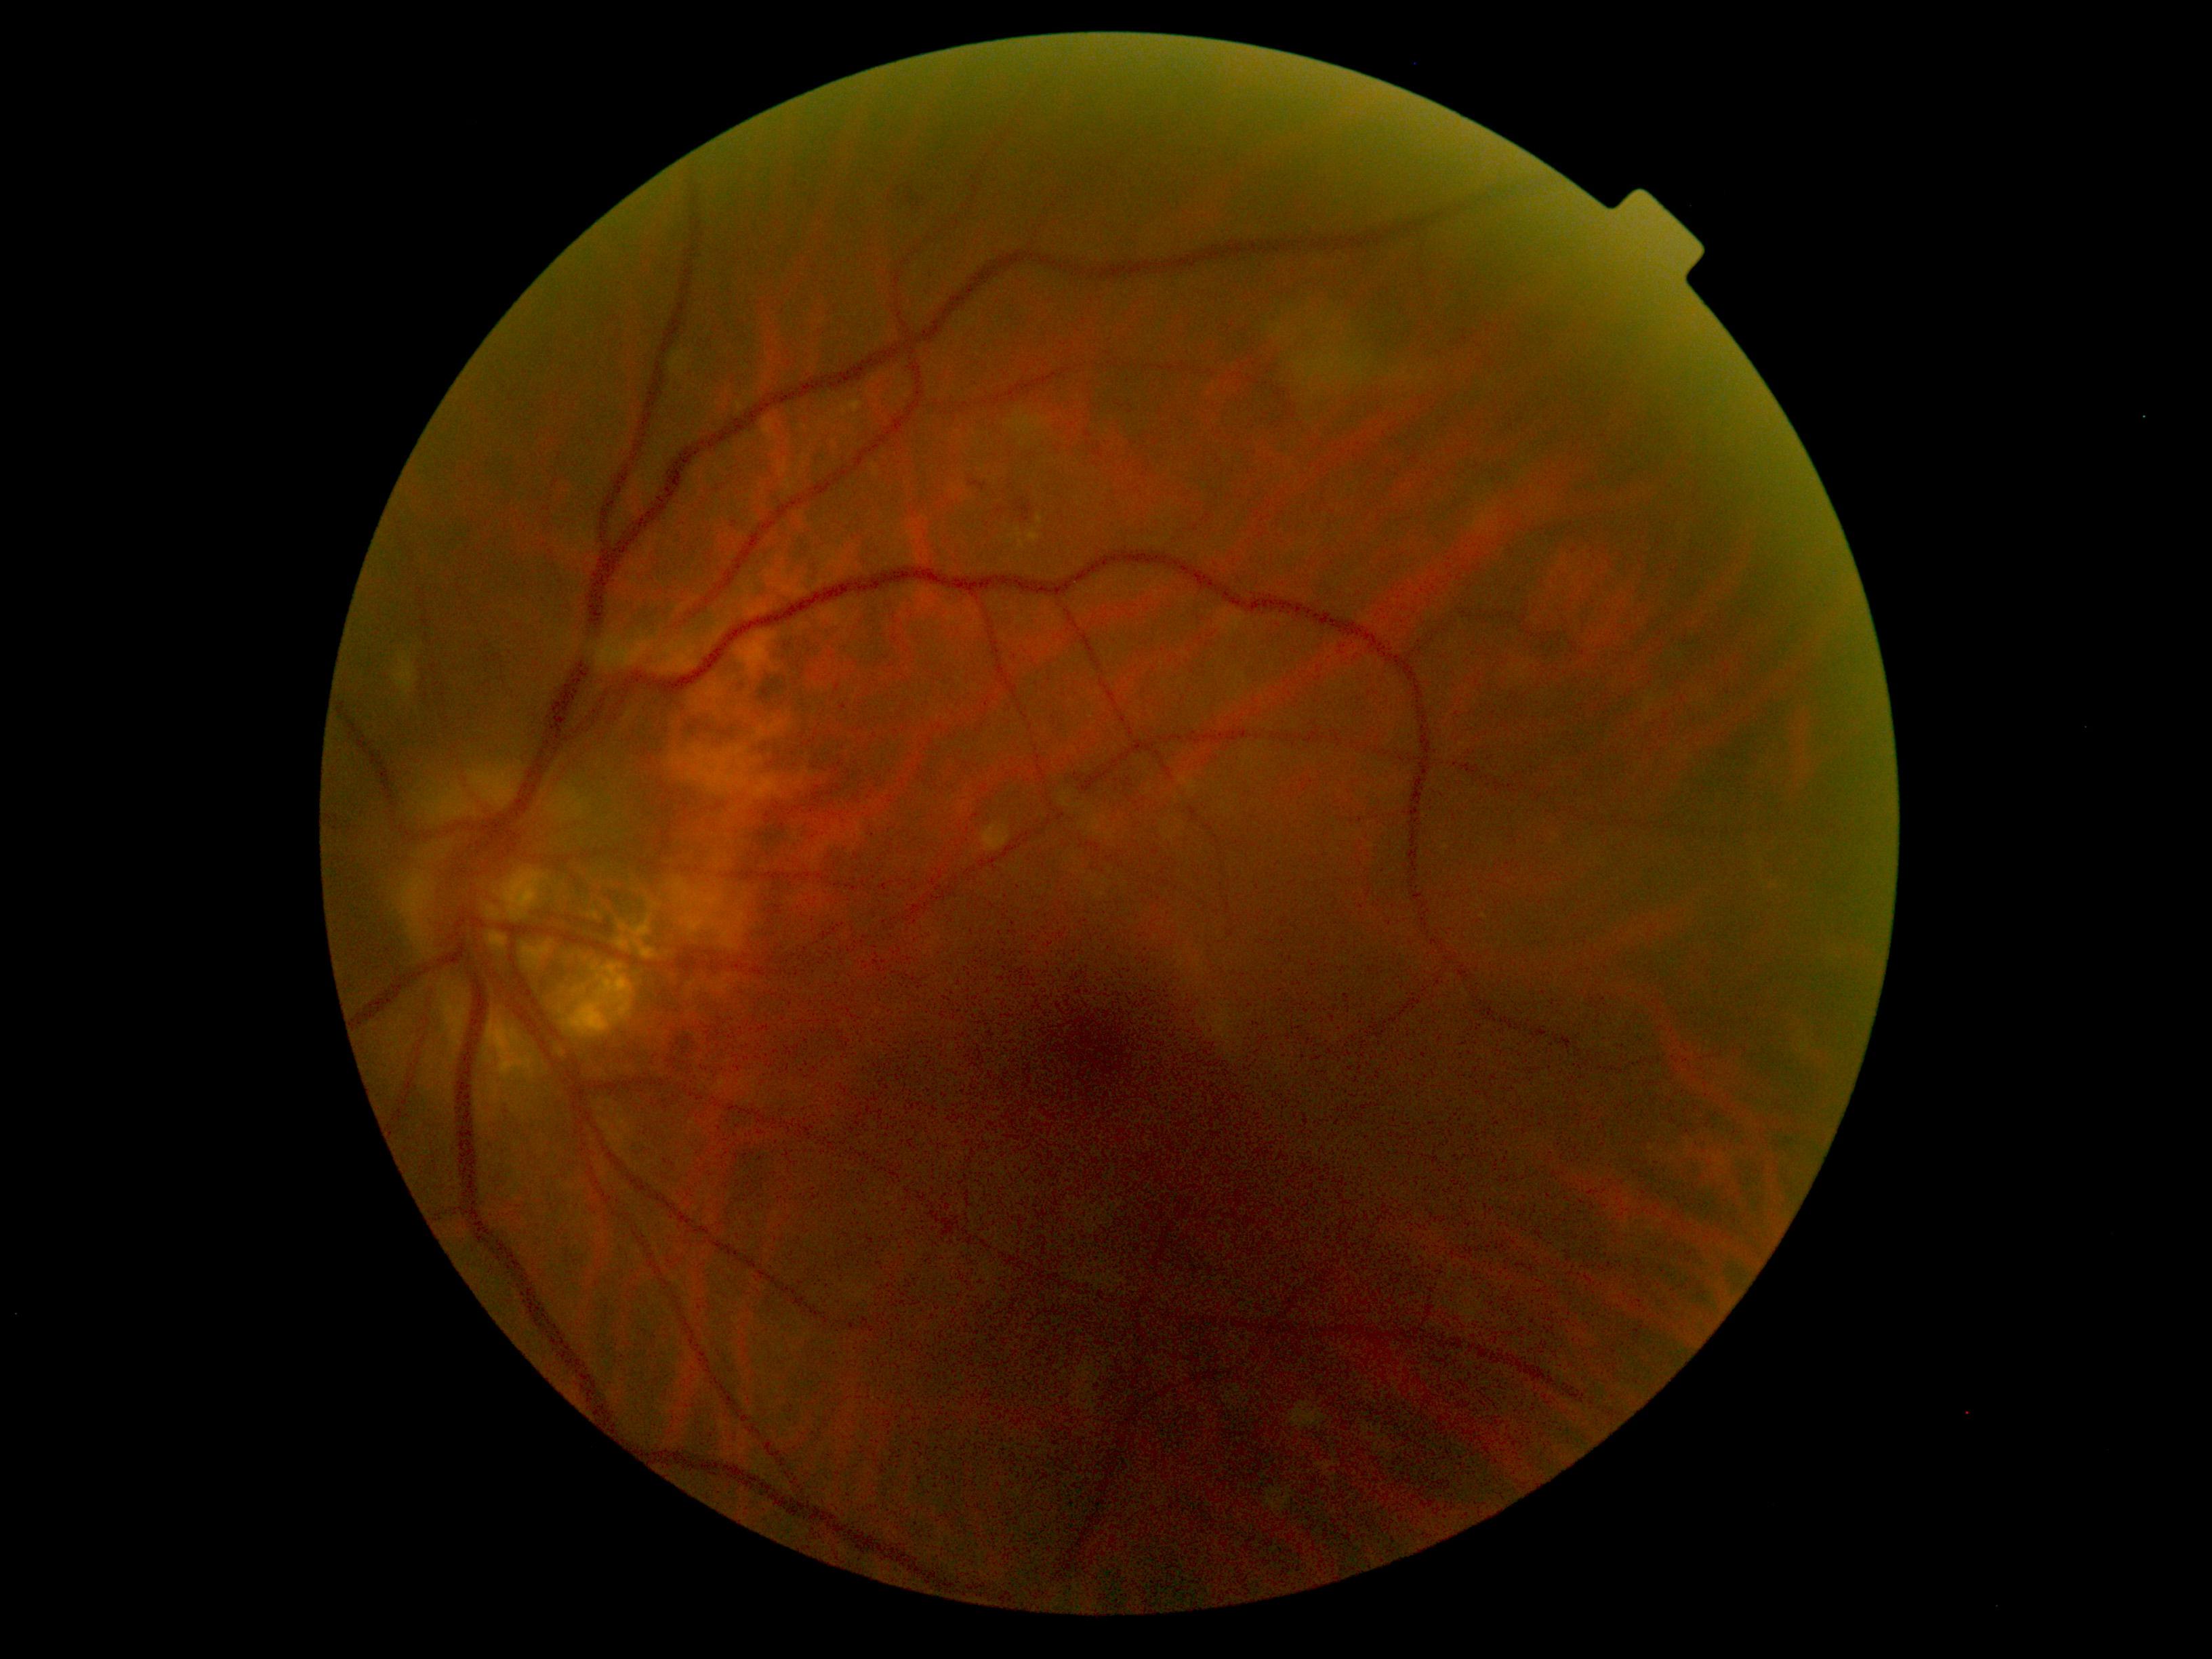

DR=grade 2 — more than just microaneurysms but less than severe NPDR.